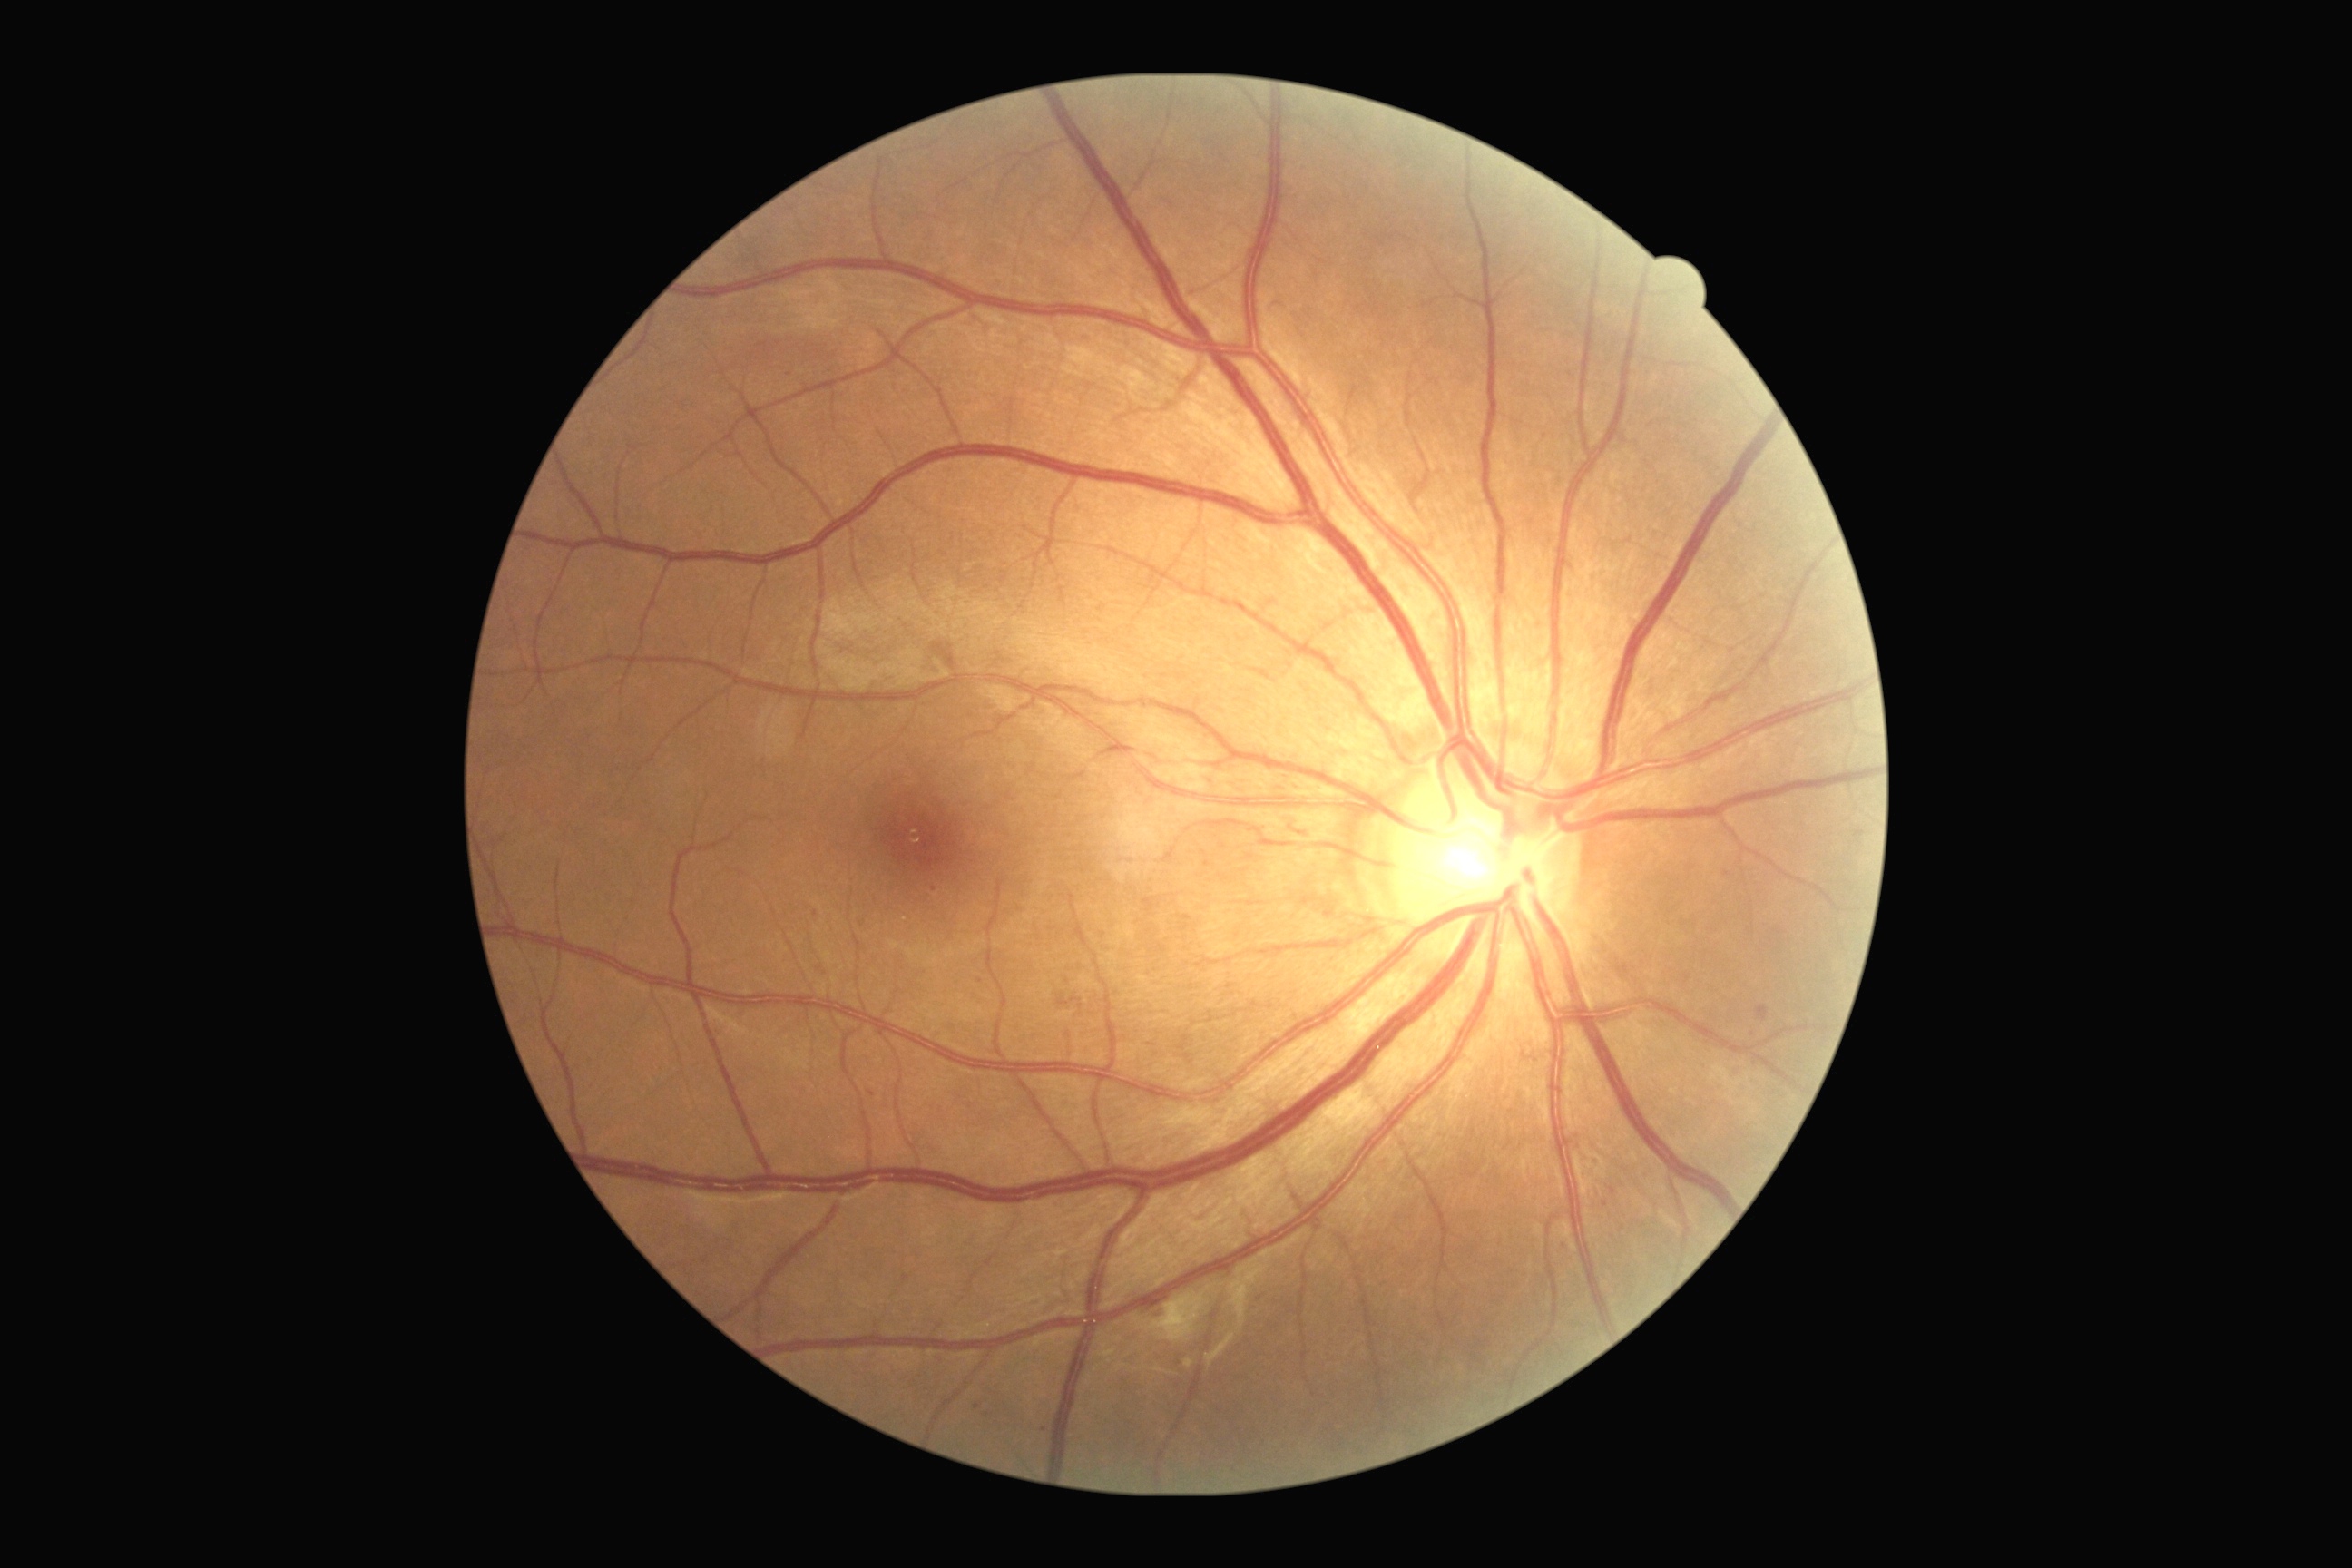

Diabetic retinopathy: 2.